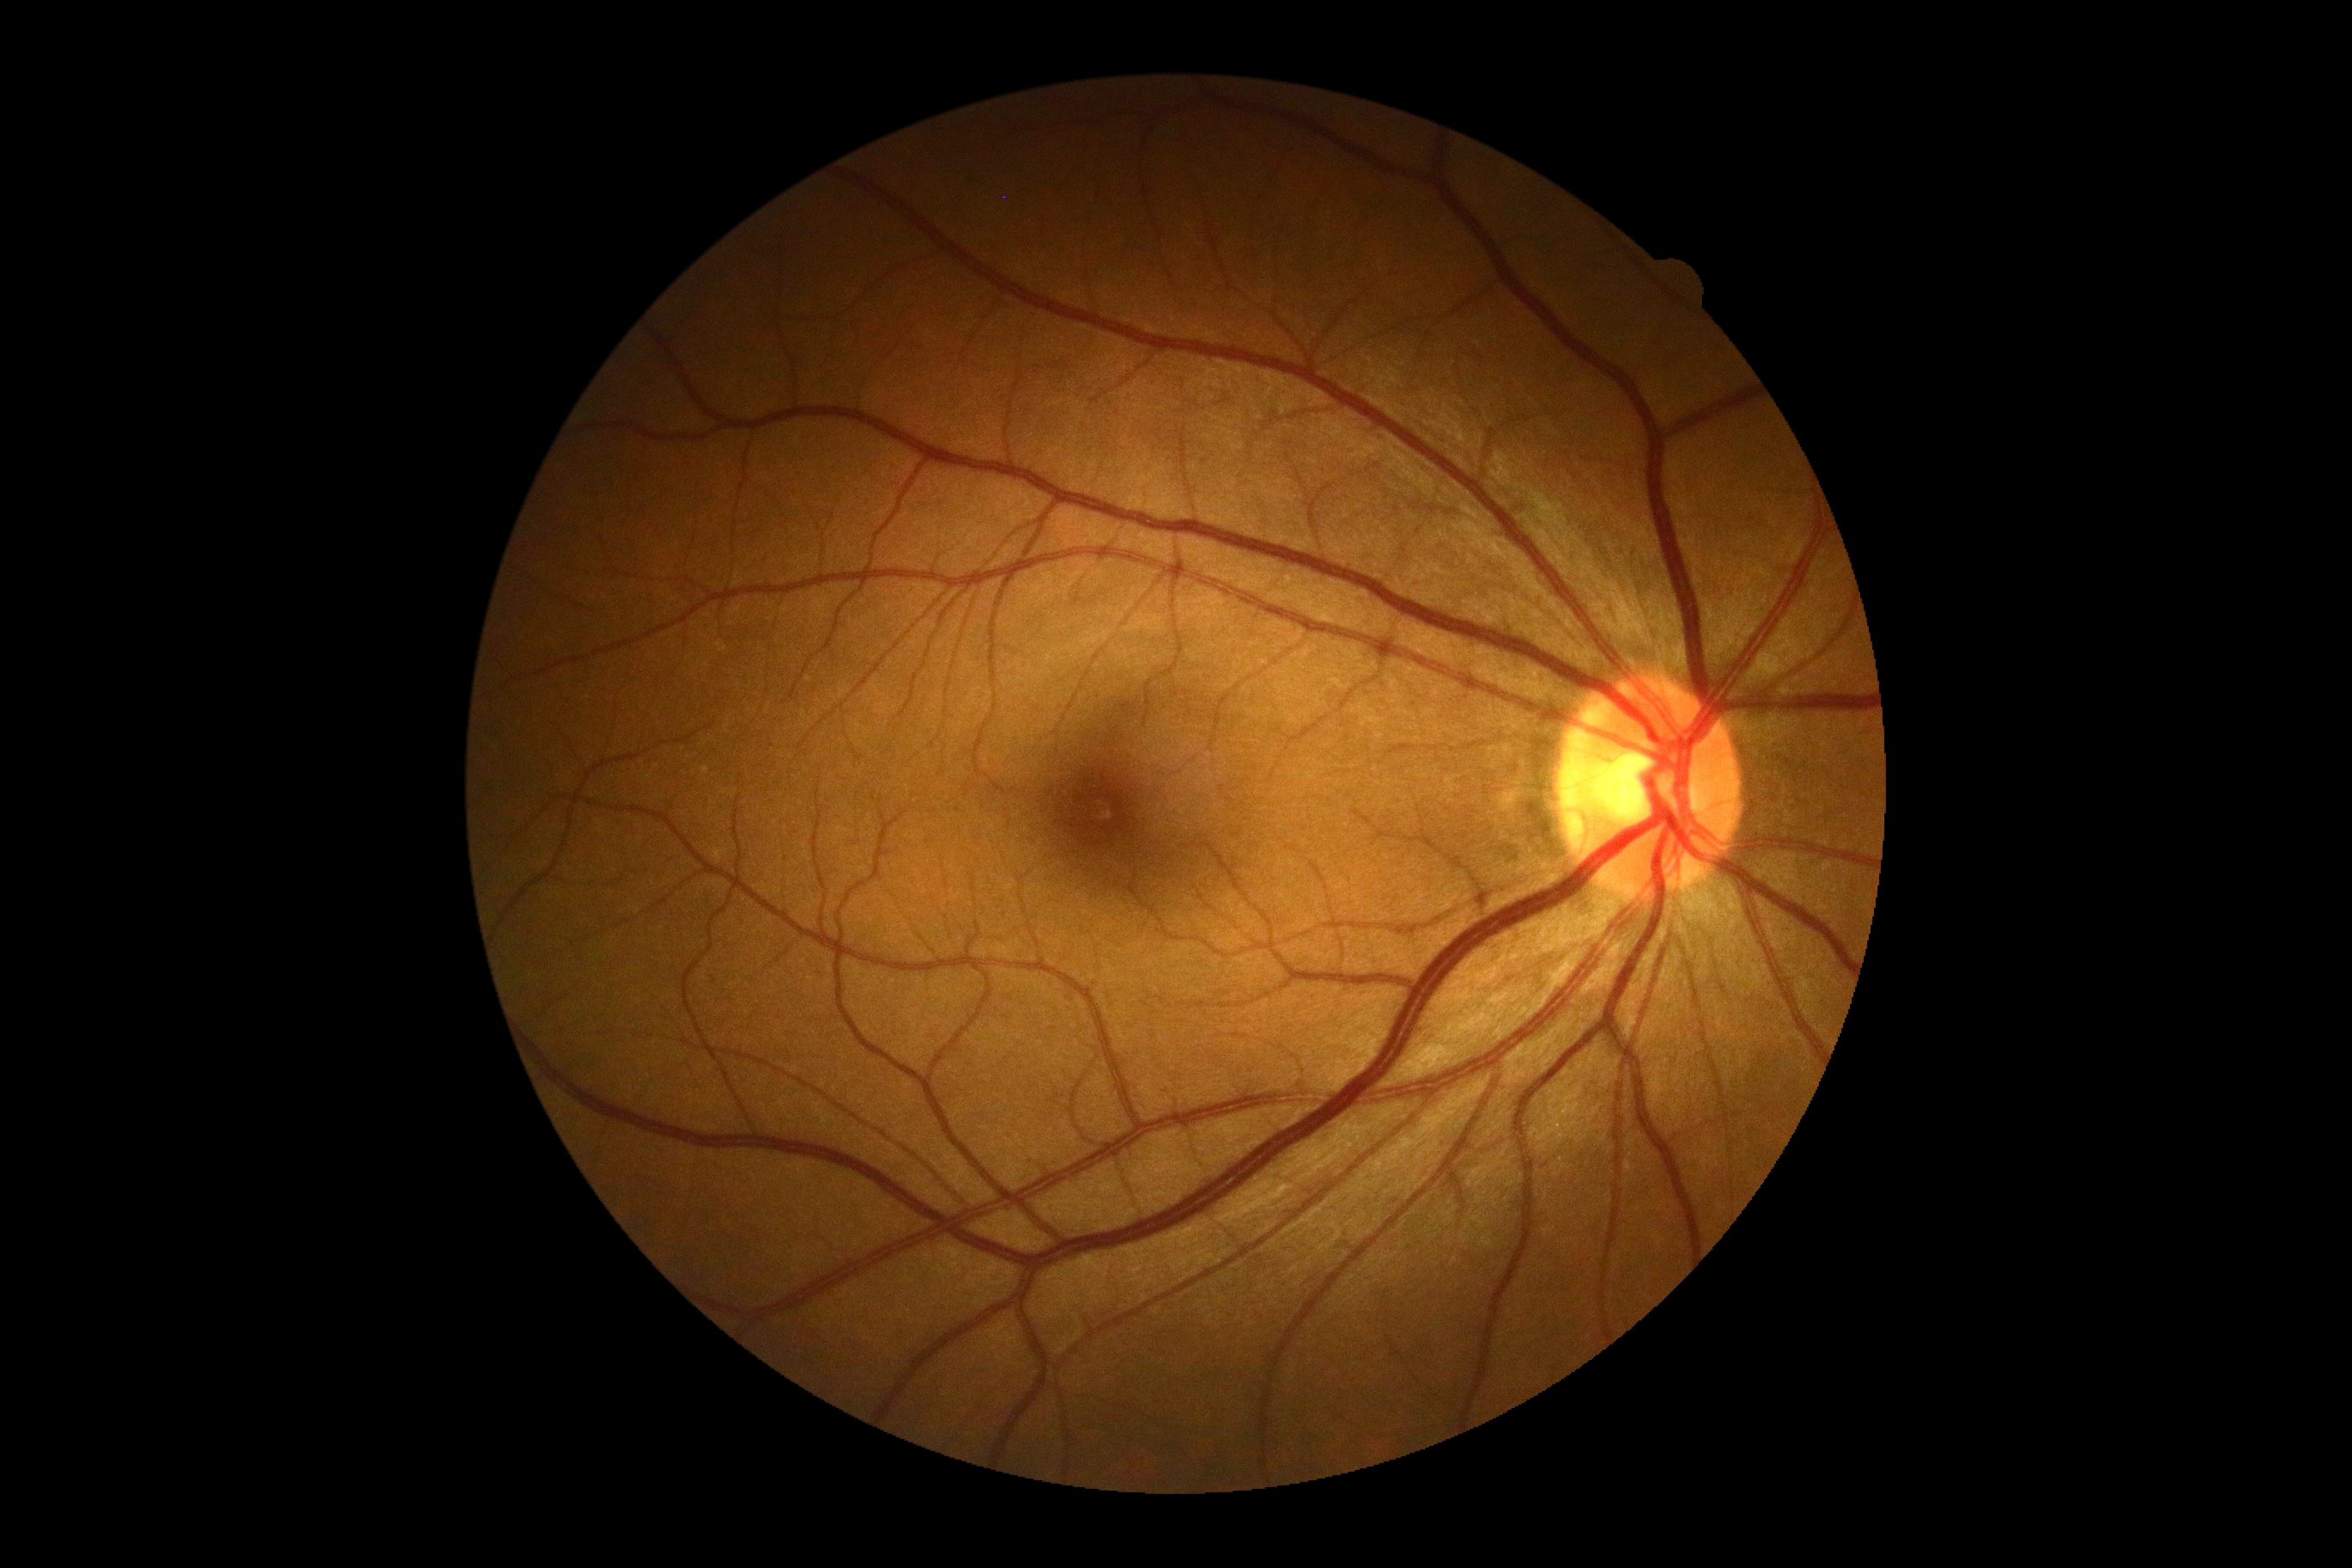   dr_grade: no apparent diabetic retinopathy (grade 0)